Wide-field fundus photograph from neonatal ROP screening · Clarity RetCam 3, 130° FOV · 640x480
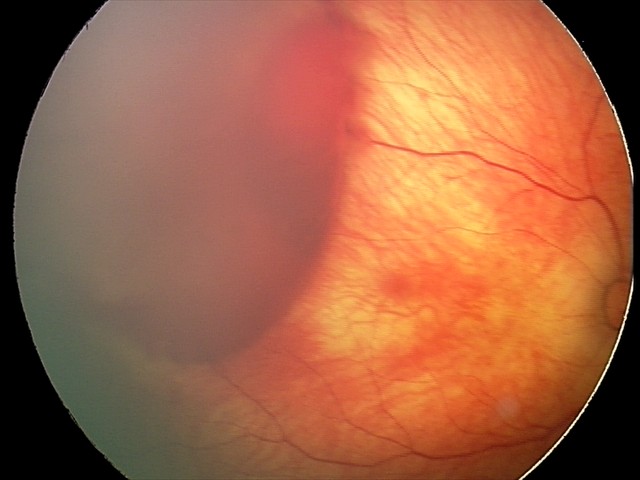 From an examination with diagnosis of retinal hemorrhages.